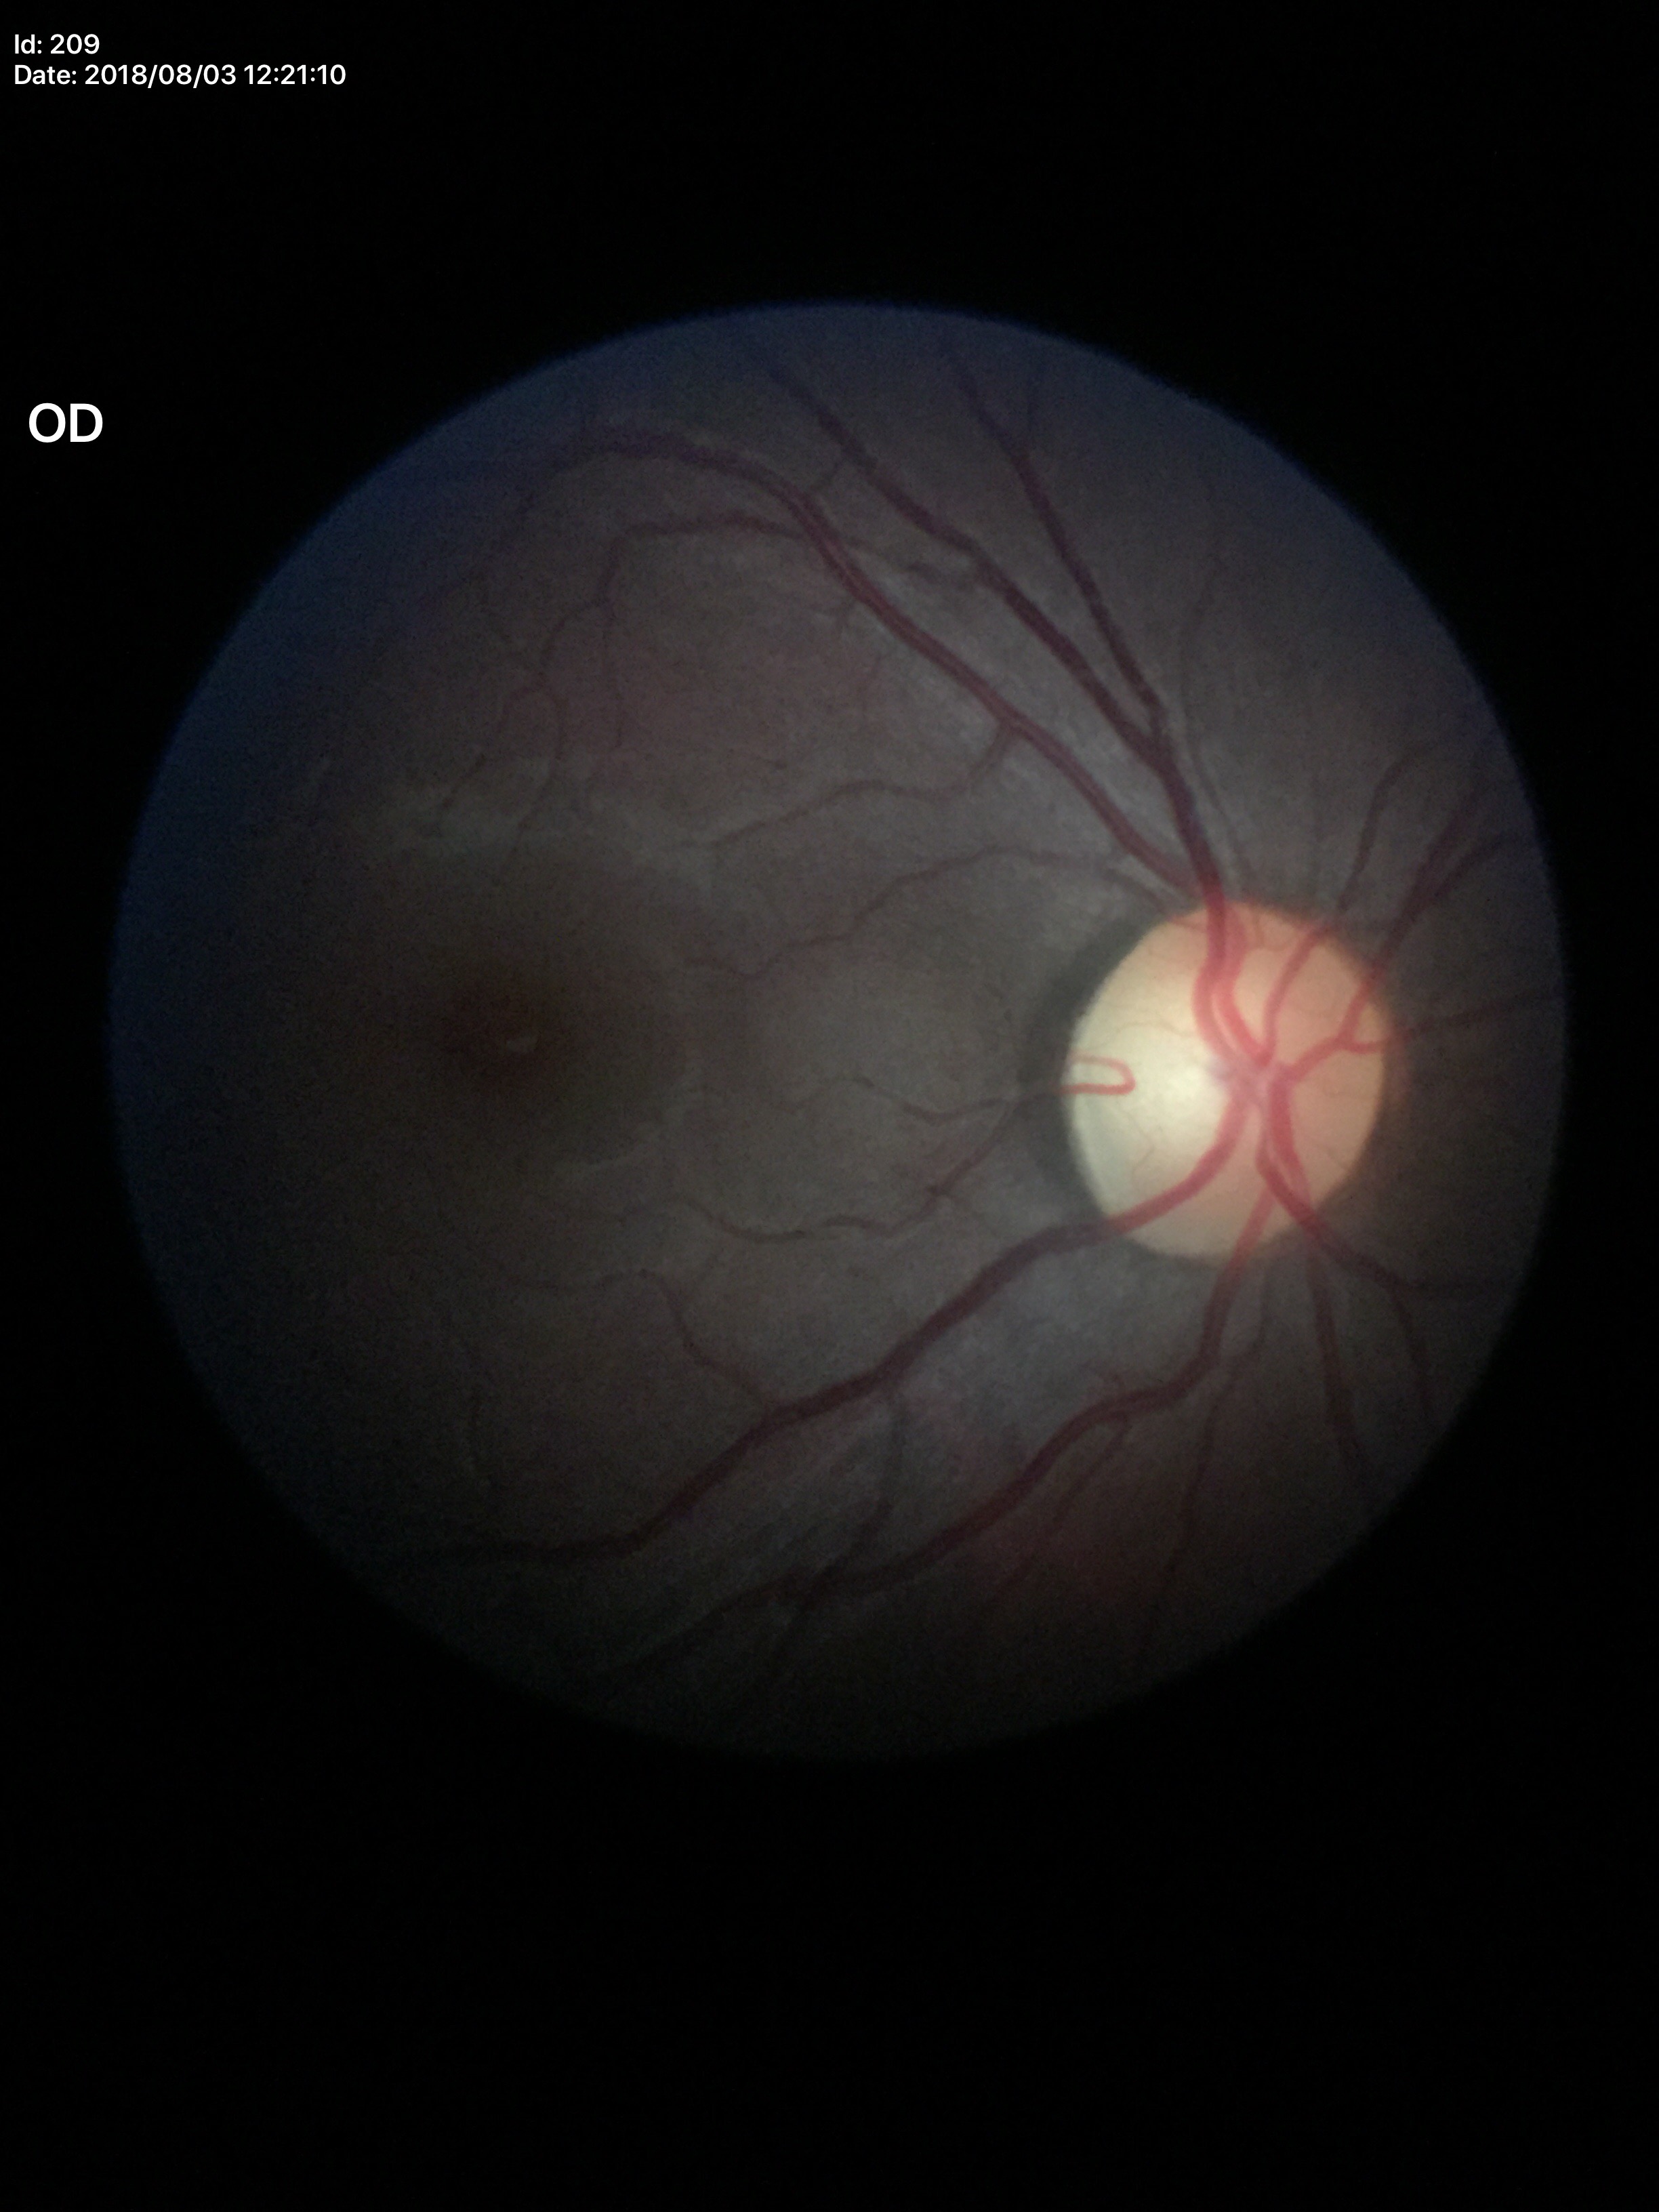
vertical cup-disc ratio (VCDR): 0.47; Glaucoma decision: not suspect; horizontal cup-disc ratio (HCDR): 0.48.